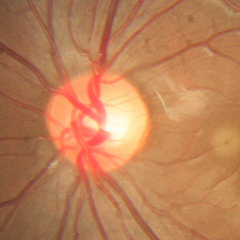

Optic nerve head appearance consistent with no glaucomatous changes.